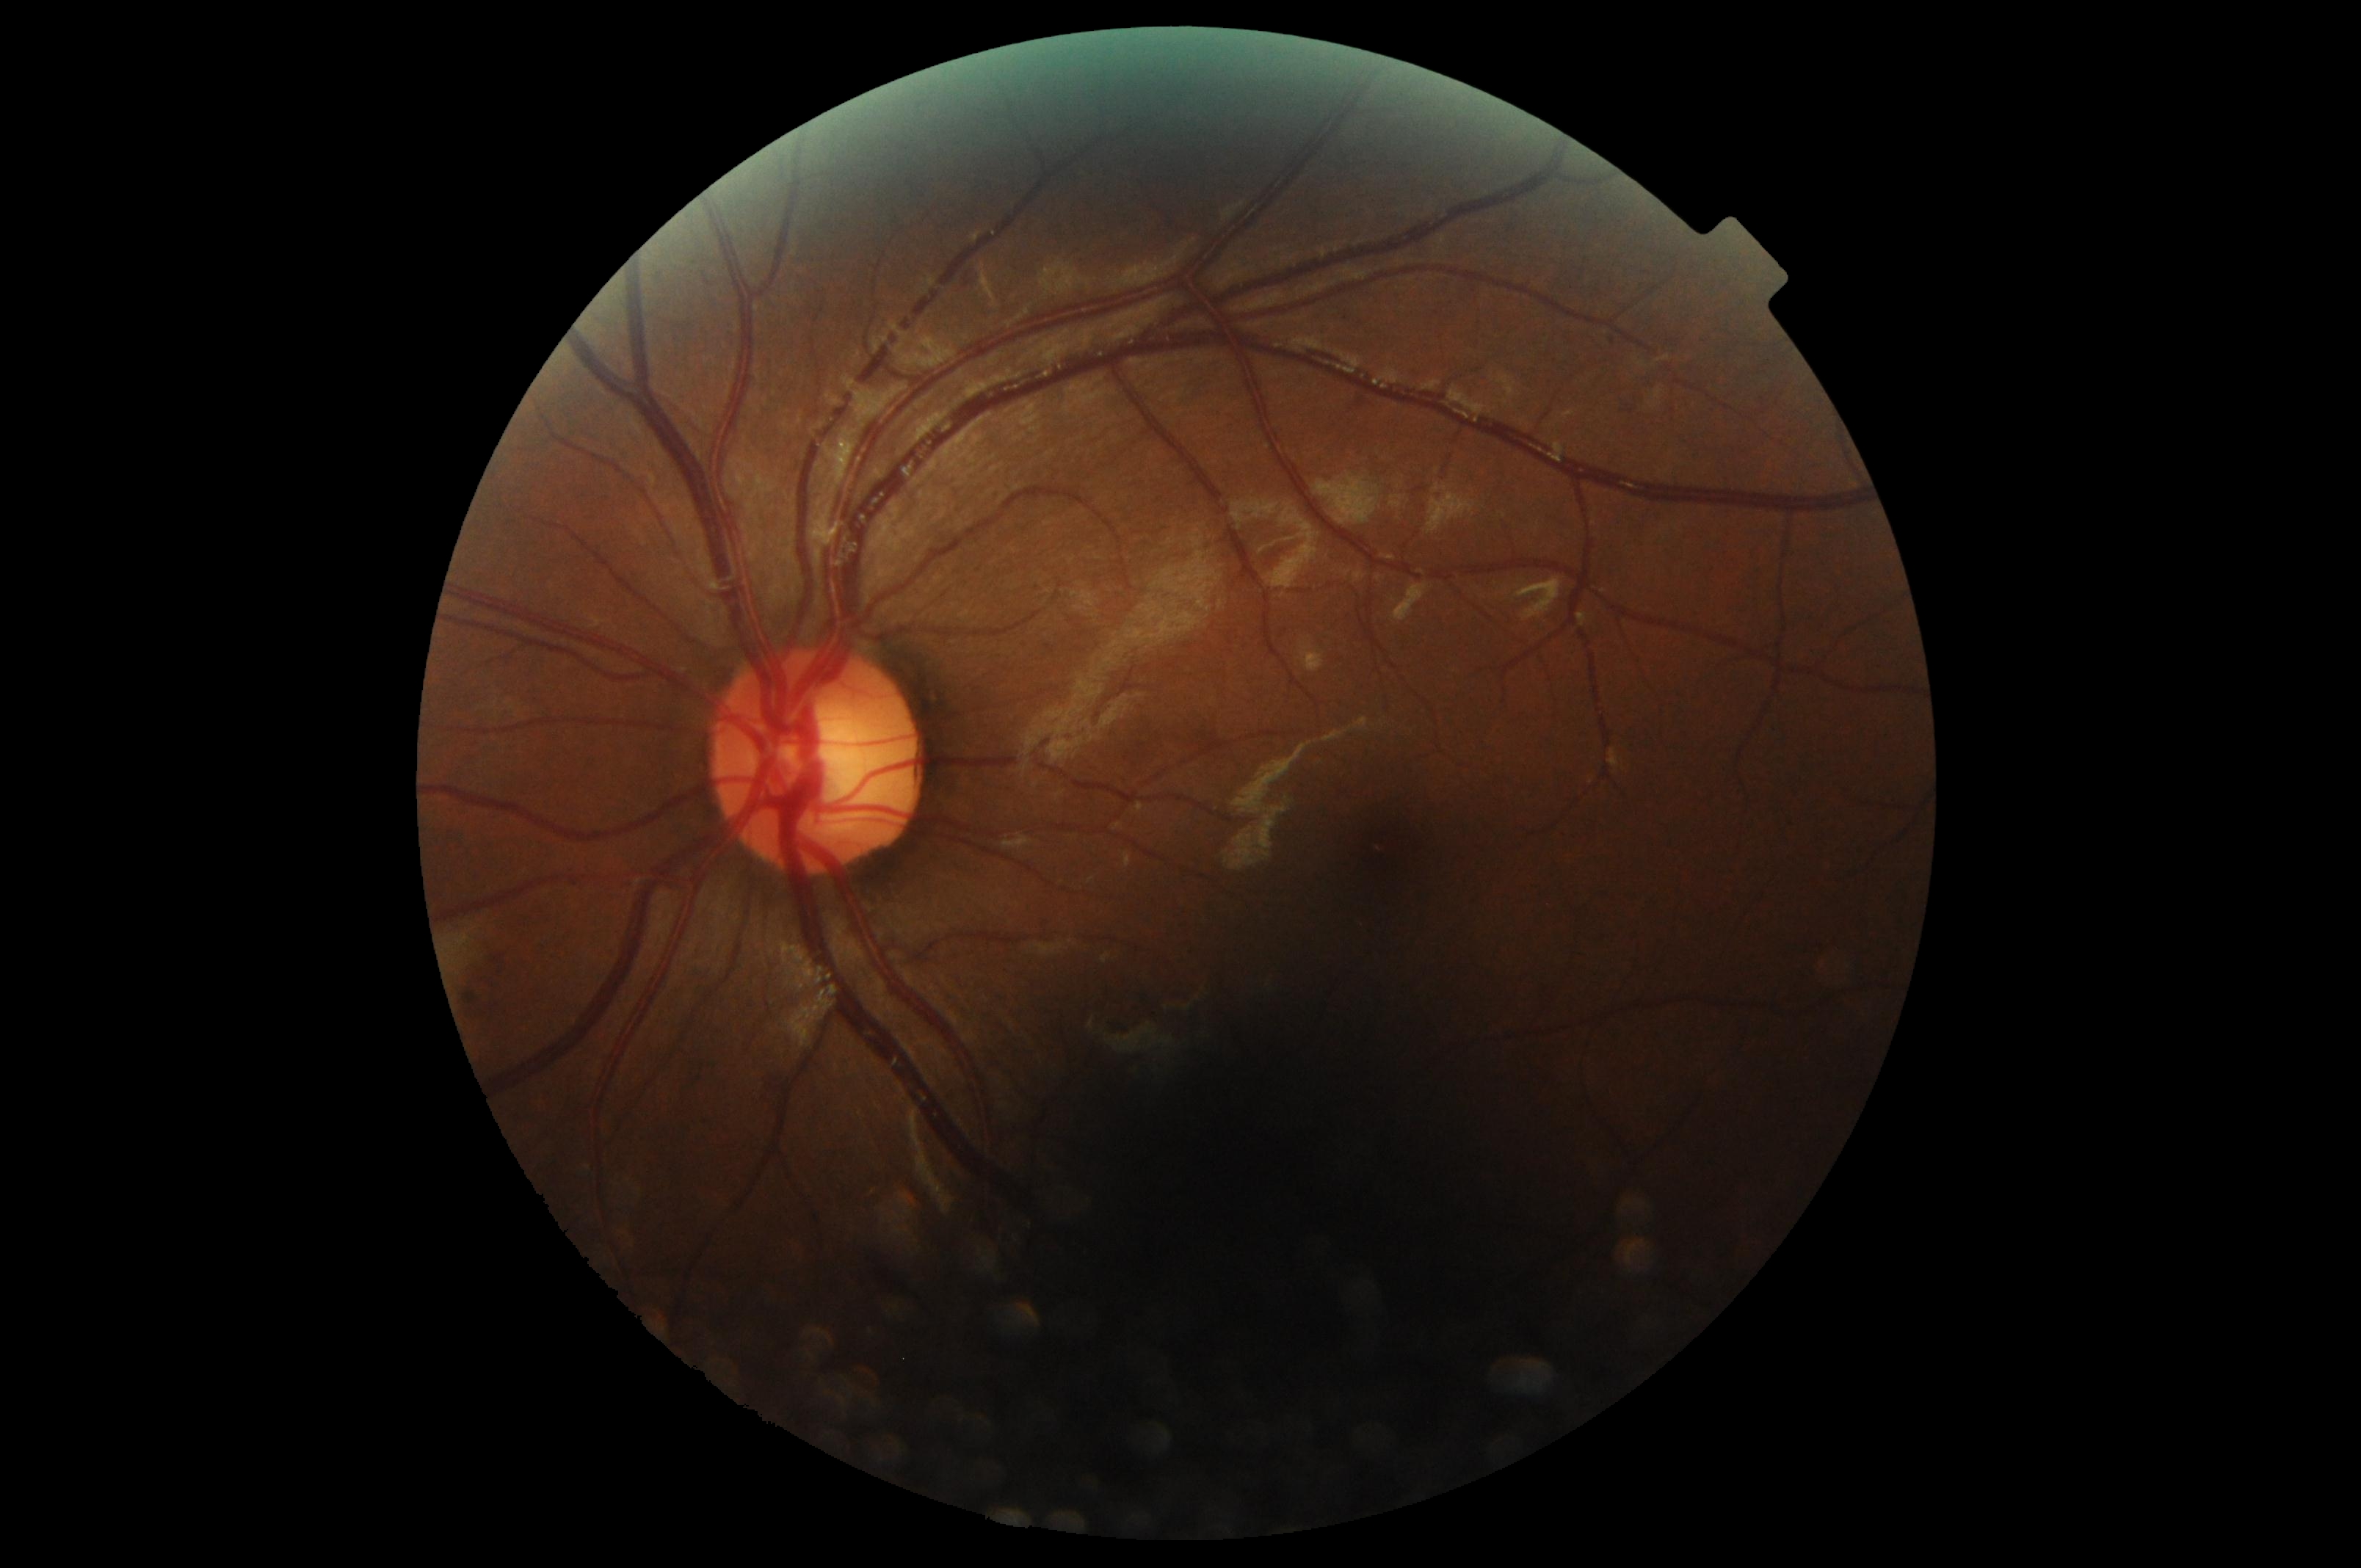 {"dr_grade": "moderate NPDR (grade 2)"}